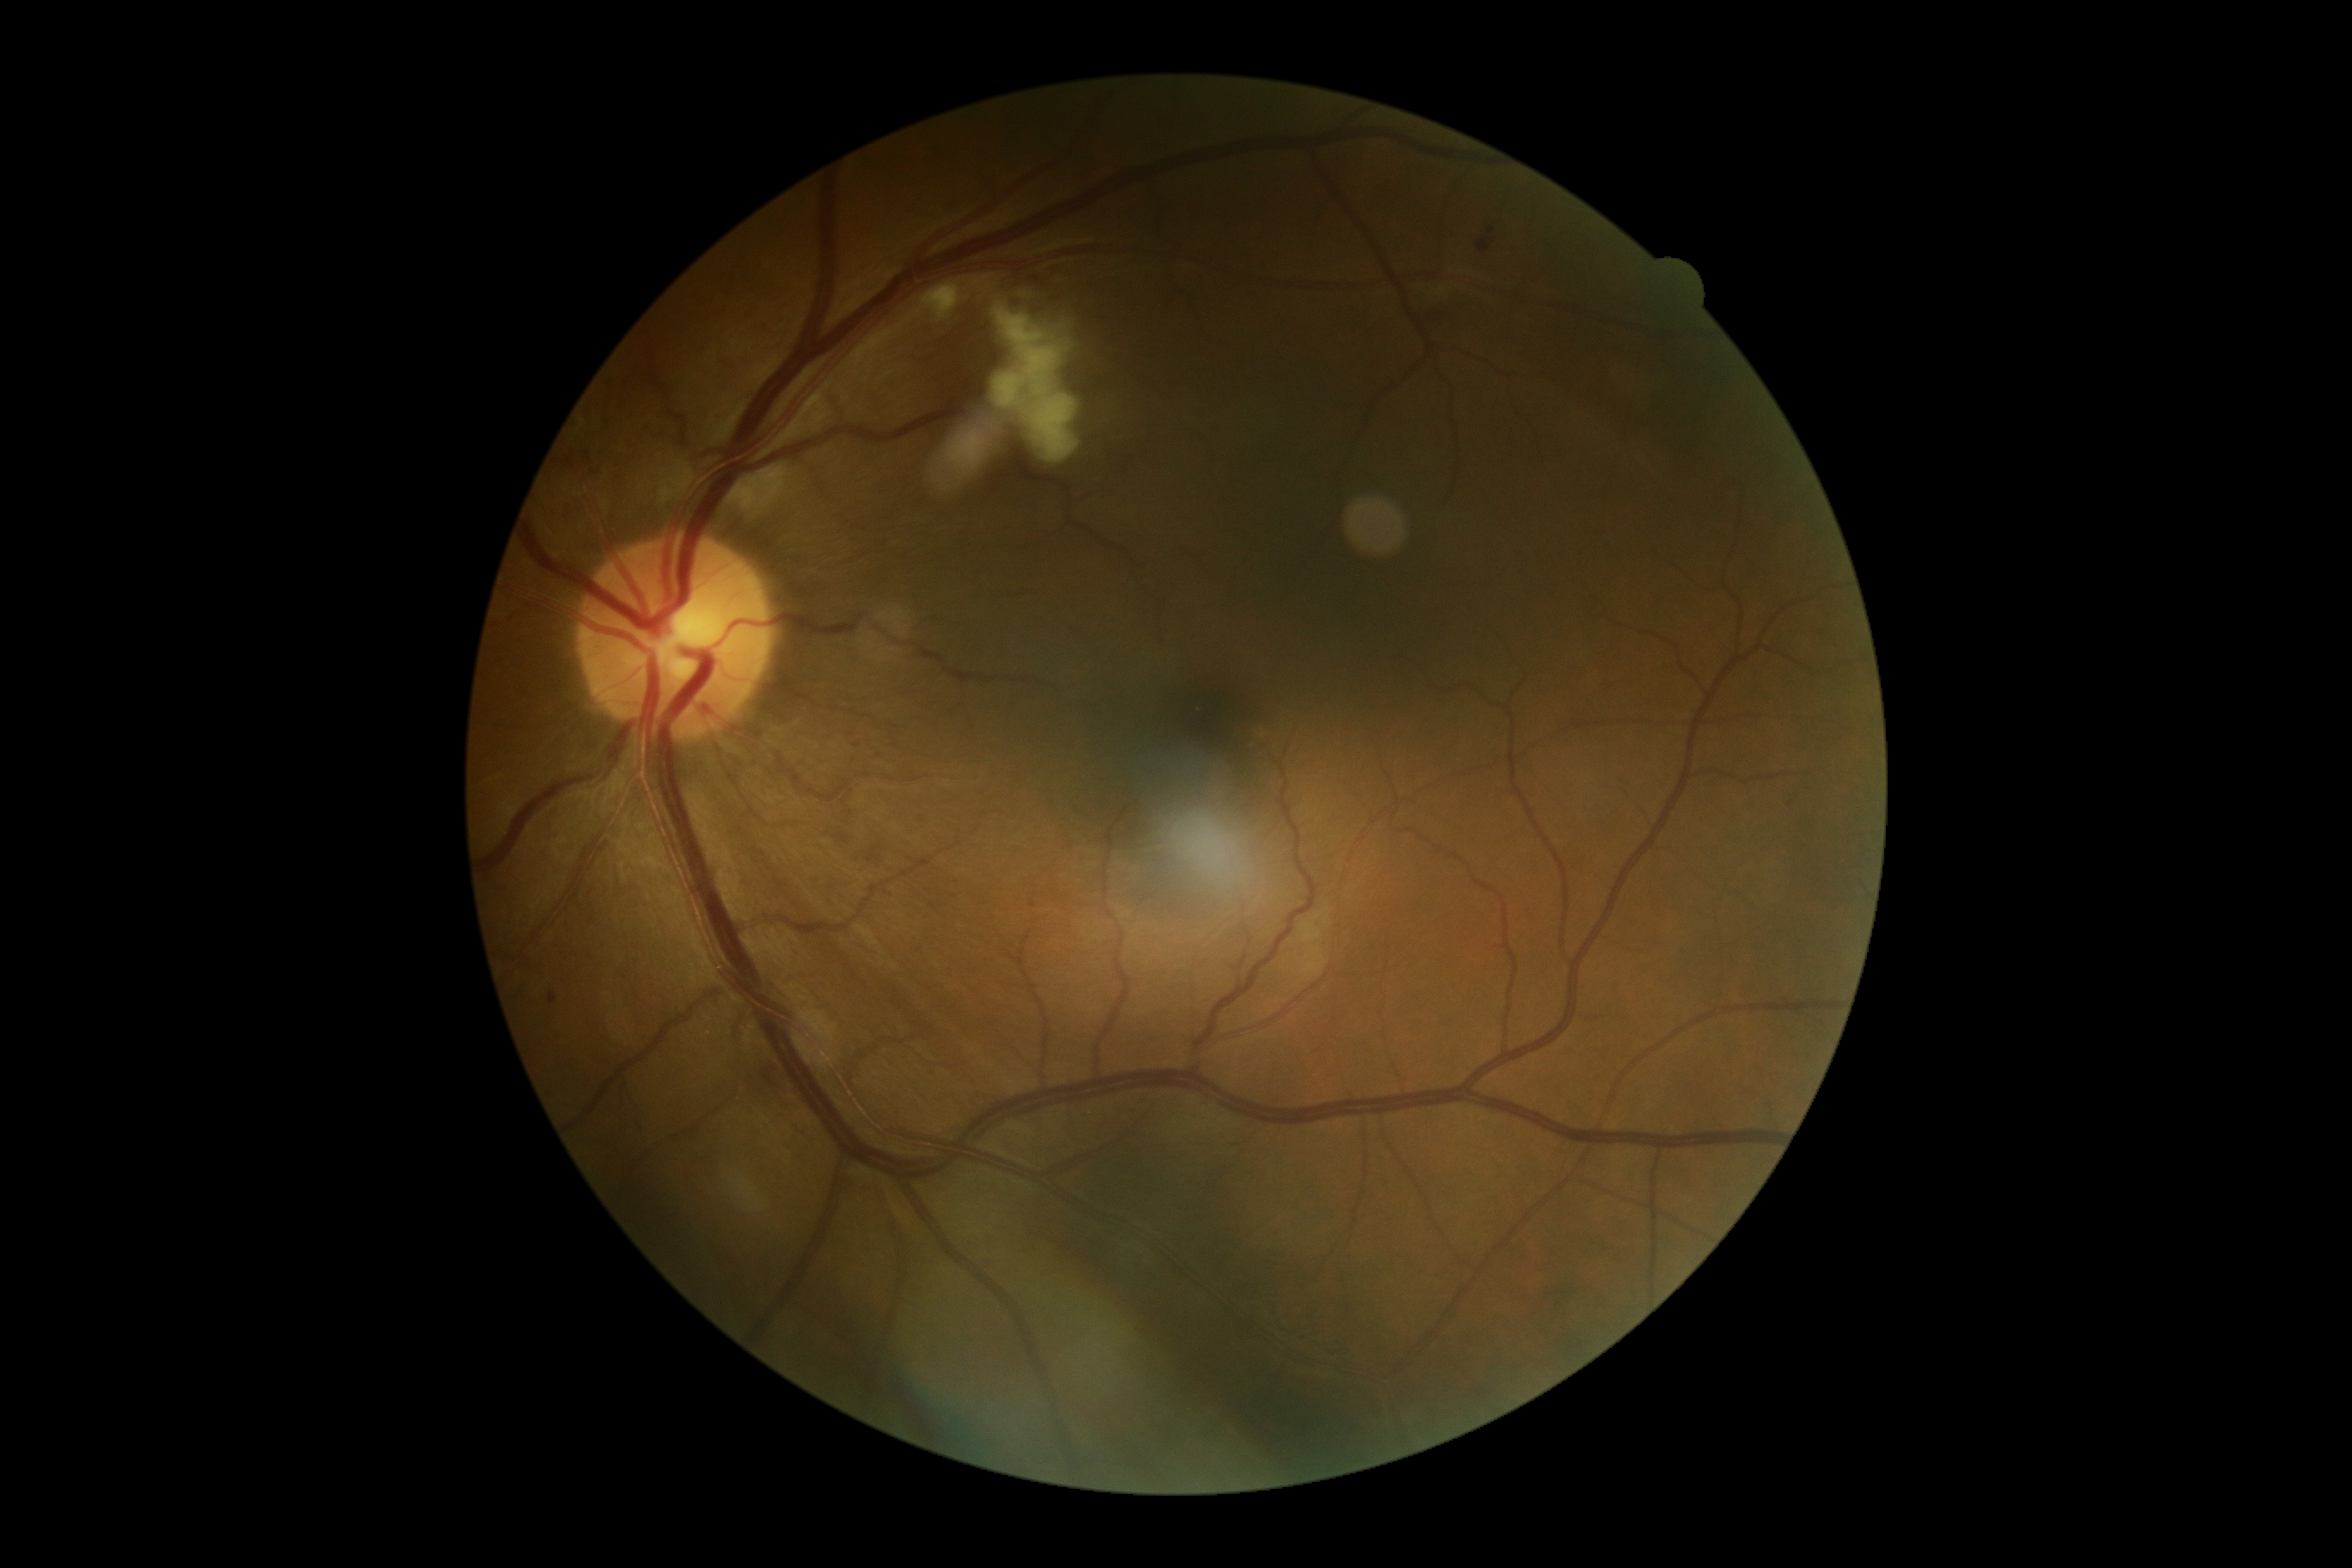 Diabetic retinopathy (DR) is 2/4.